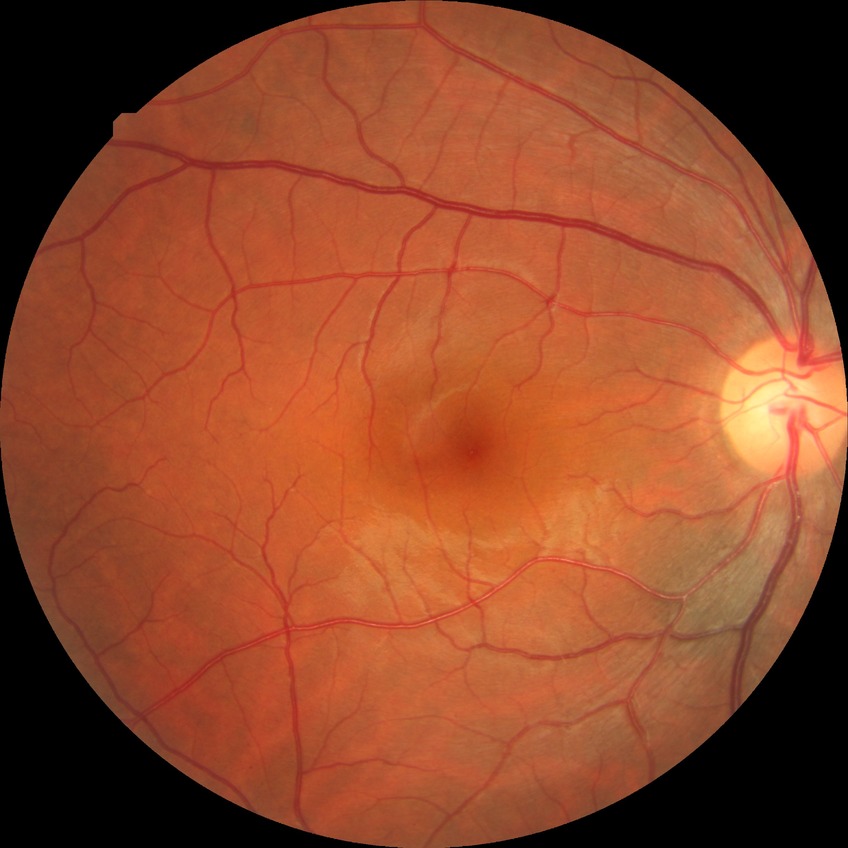 retinopathy grade=no diabetic retinopathy.